Camera: Forus 3Nethra Classic fundus camera: 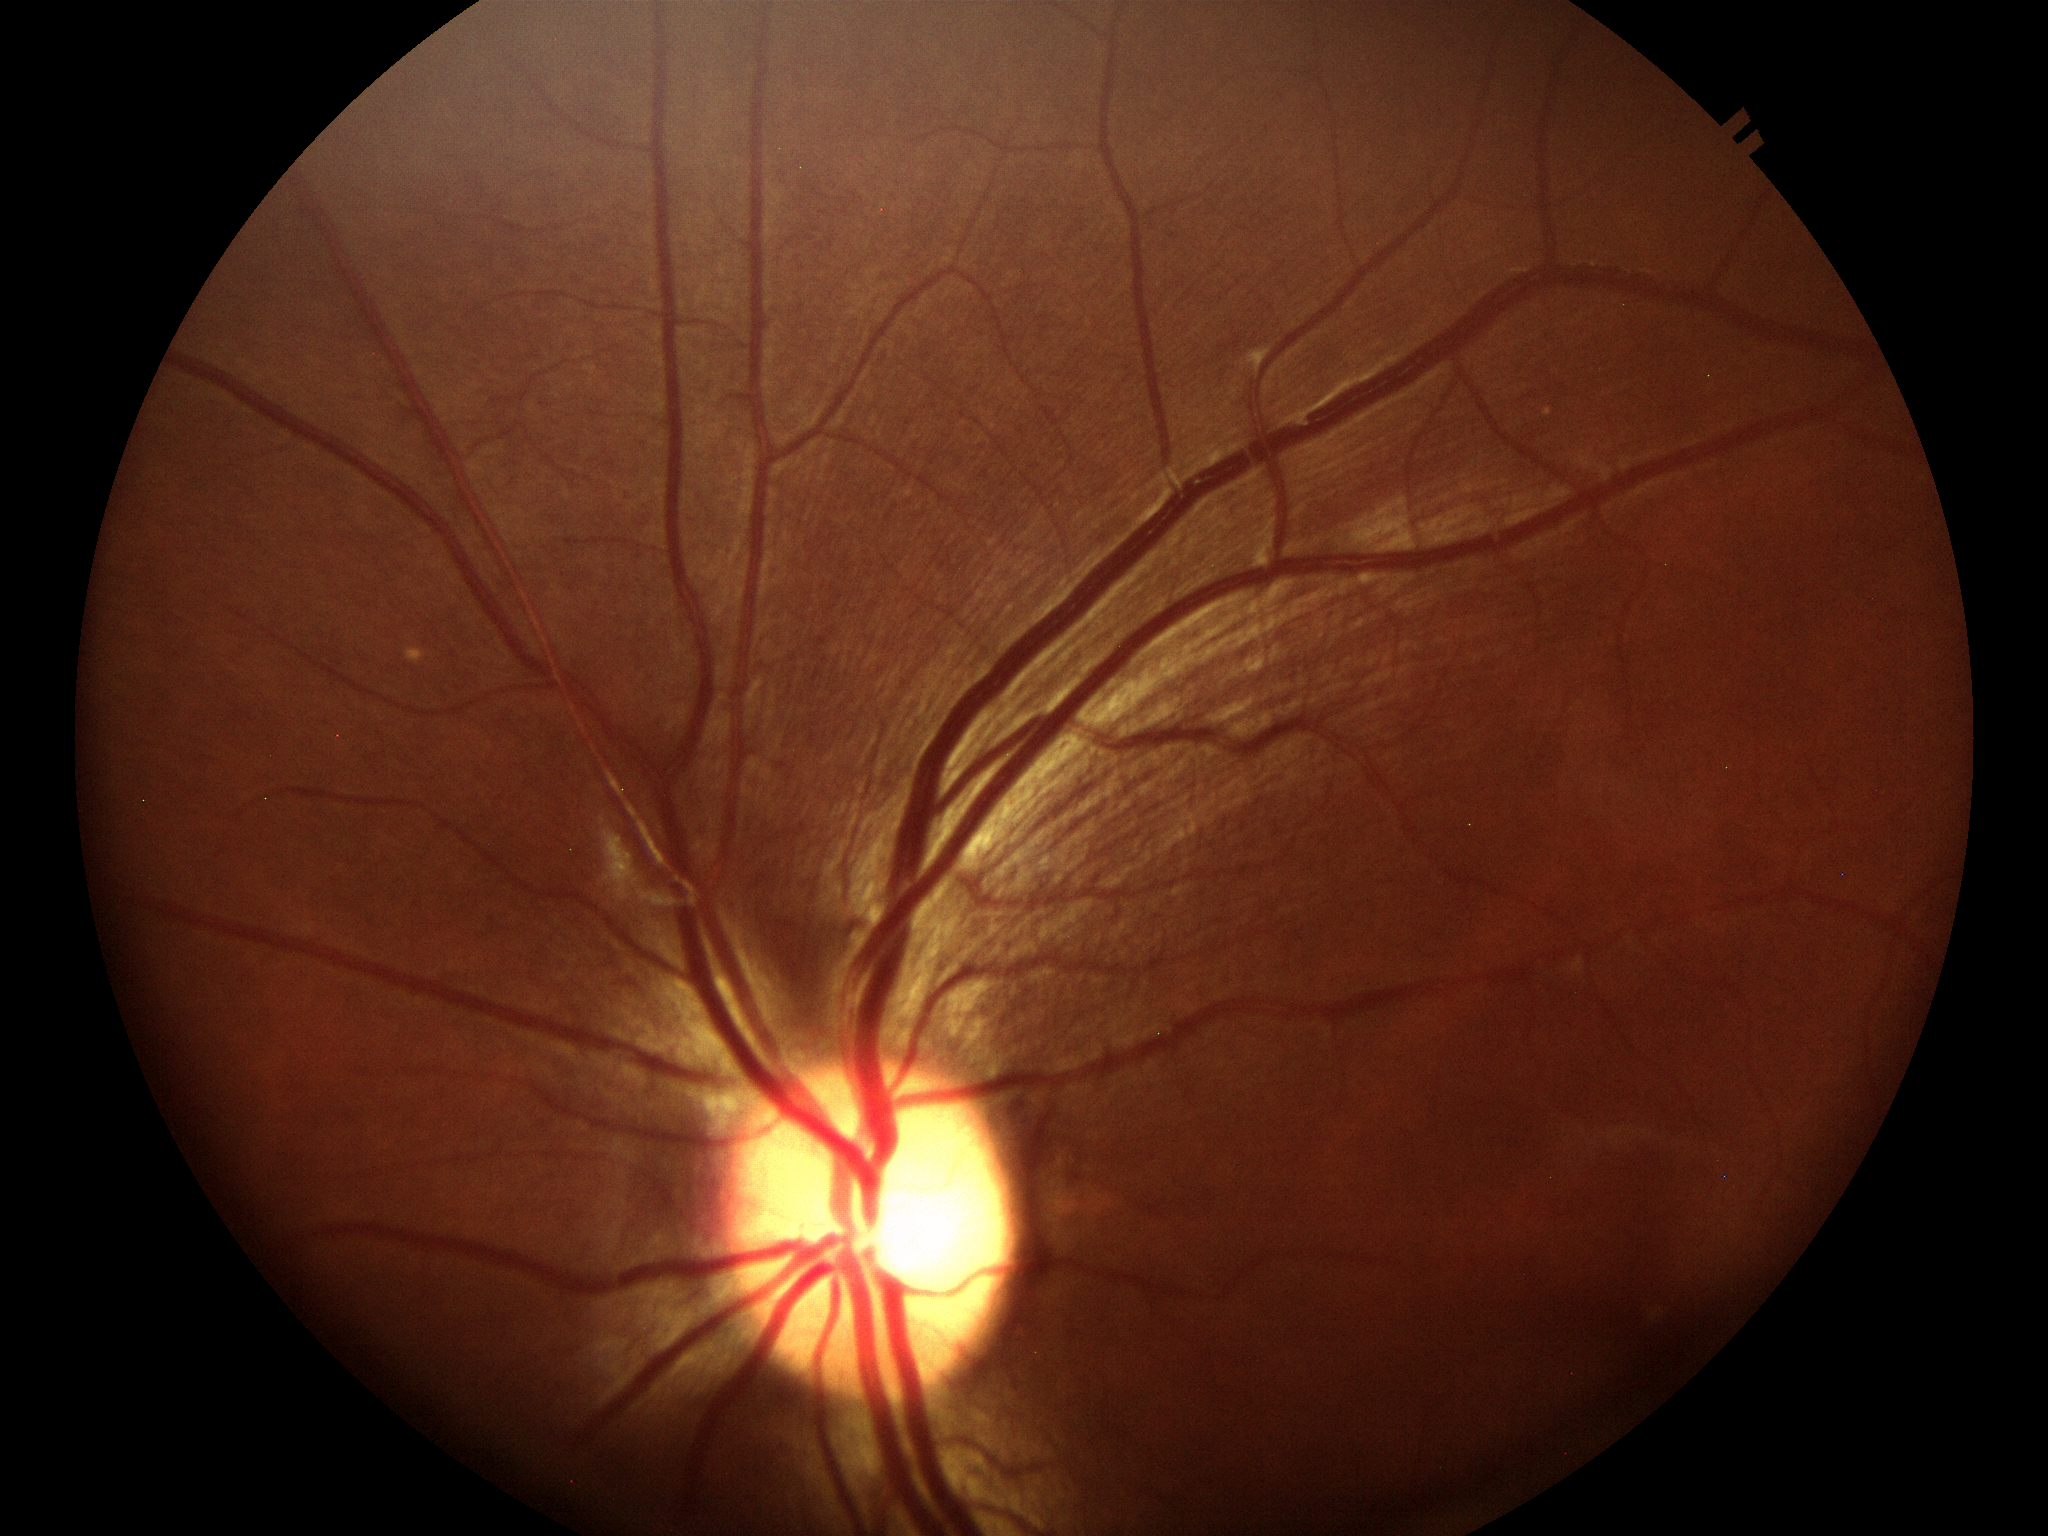 Glaucoma screening: suspect. Vertical CDR is 0.65. Horizontal cup-disc ratio of 0.63.